Pediatric wide-field fundus photograph; camera: Clarity RetCam 3 (130° FOV): 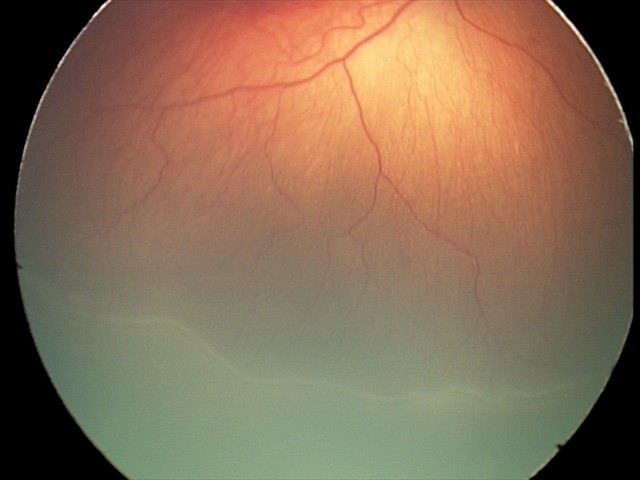
Series diagnosed as ROP stage 2 — ridge with height and width at the demarcation line.